45-degree field of view
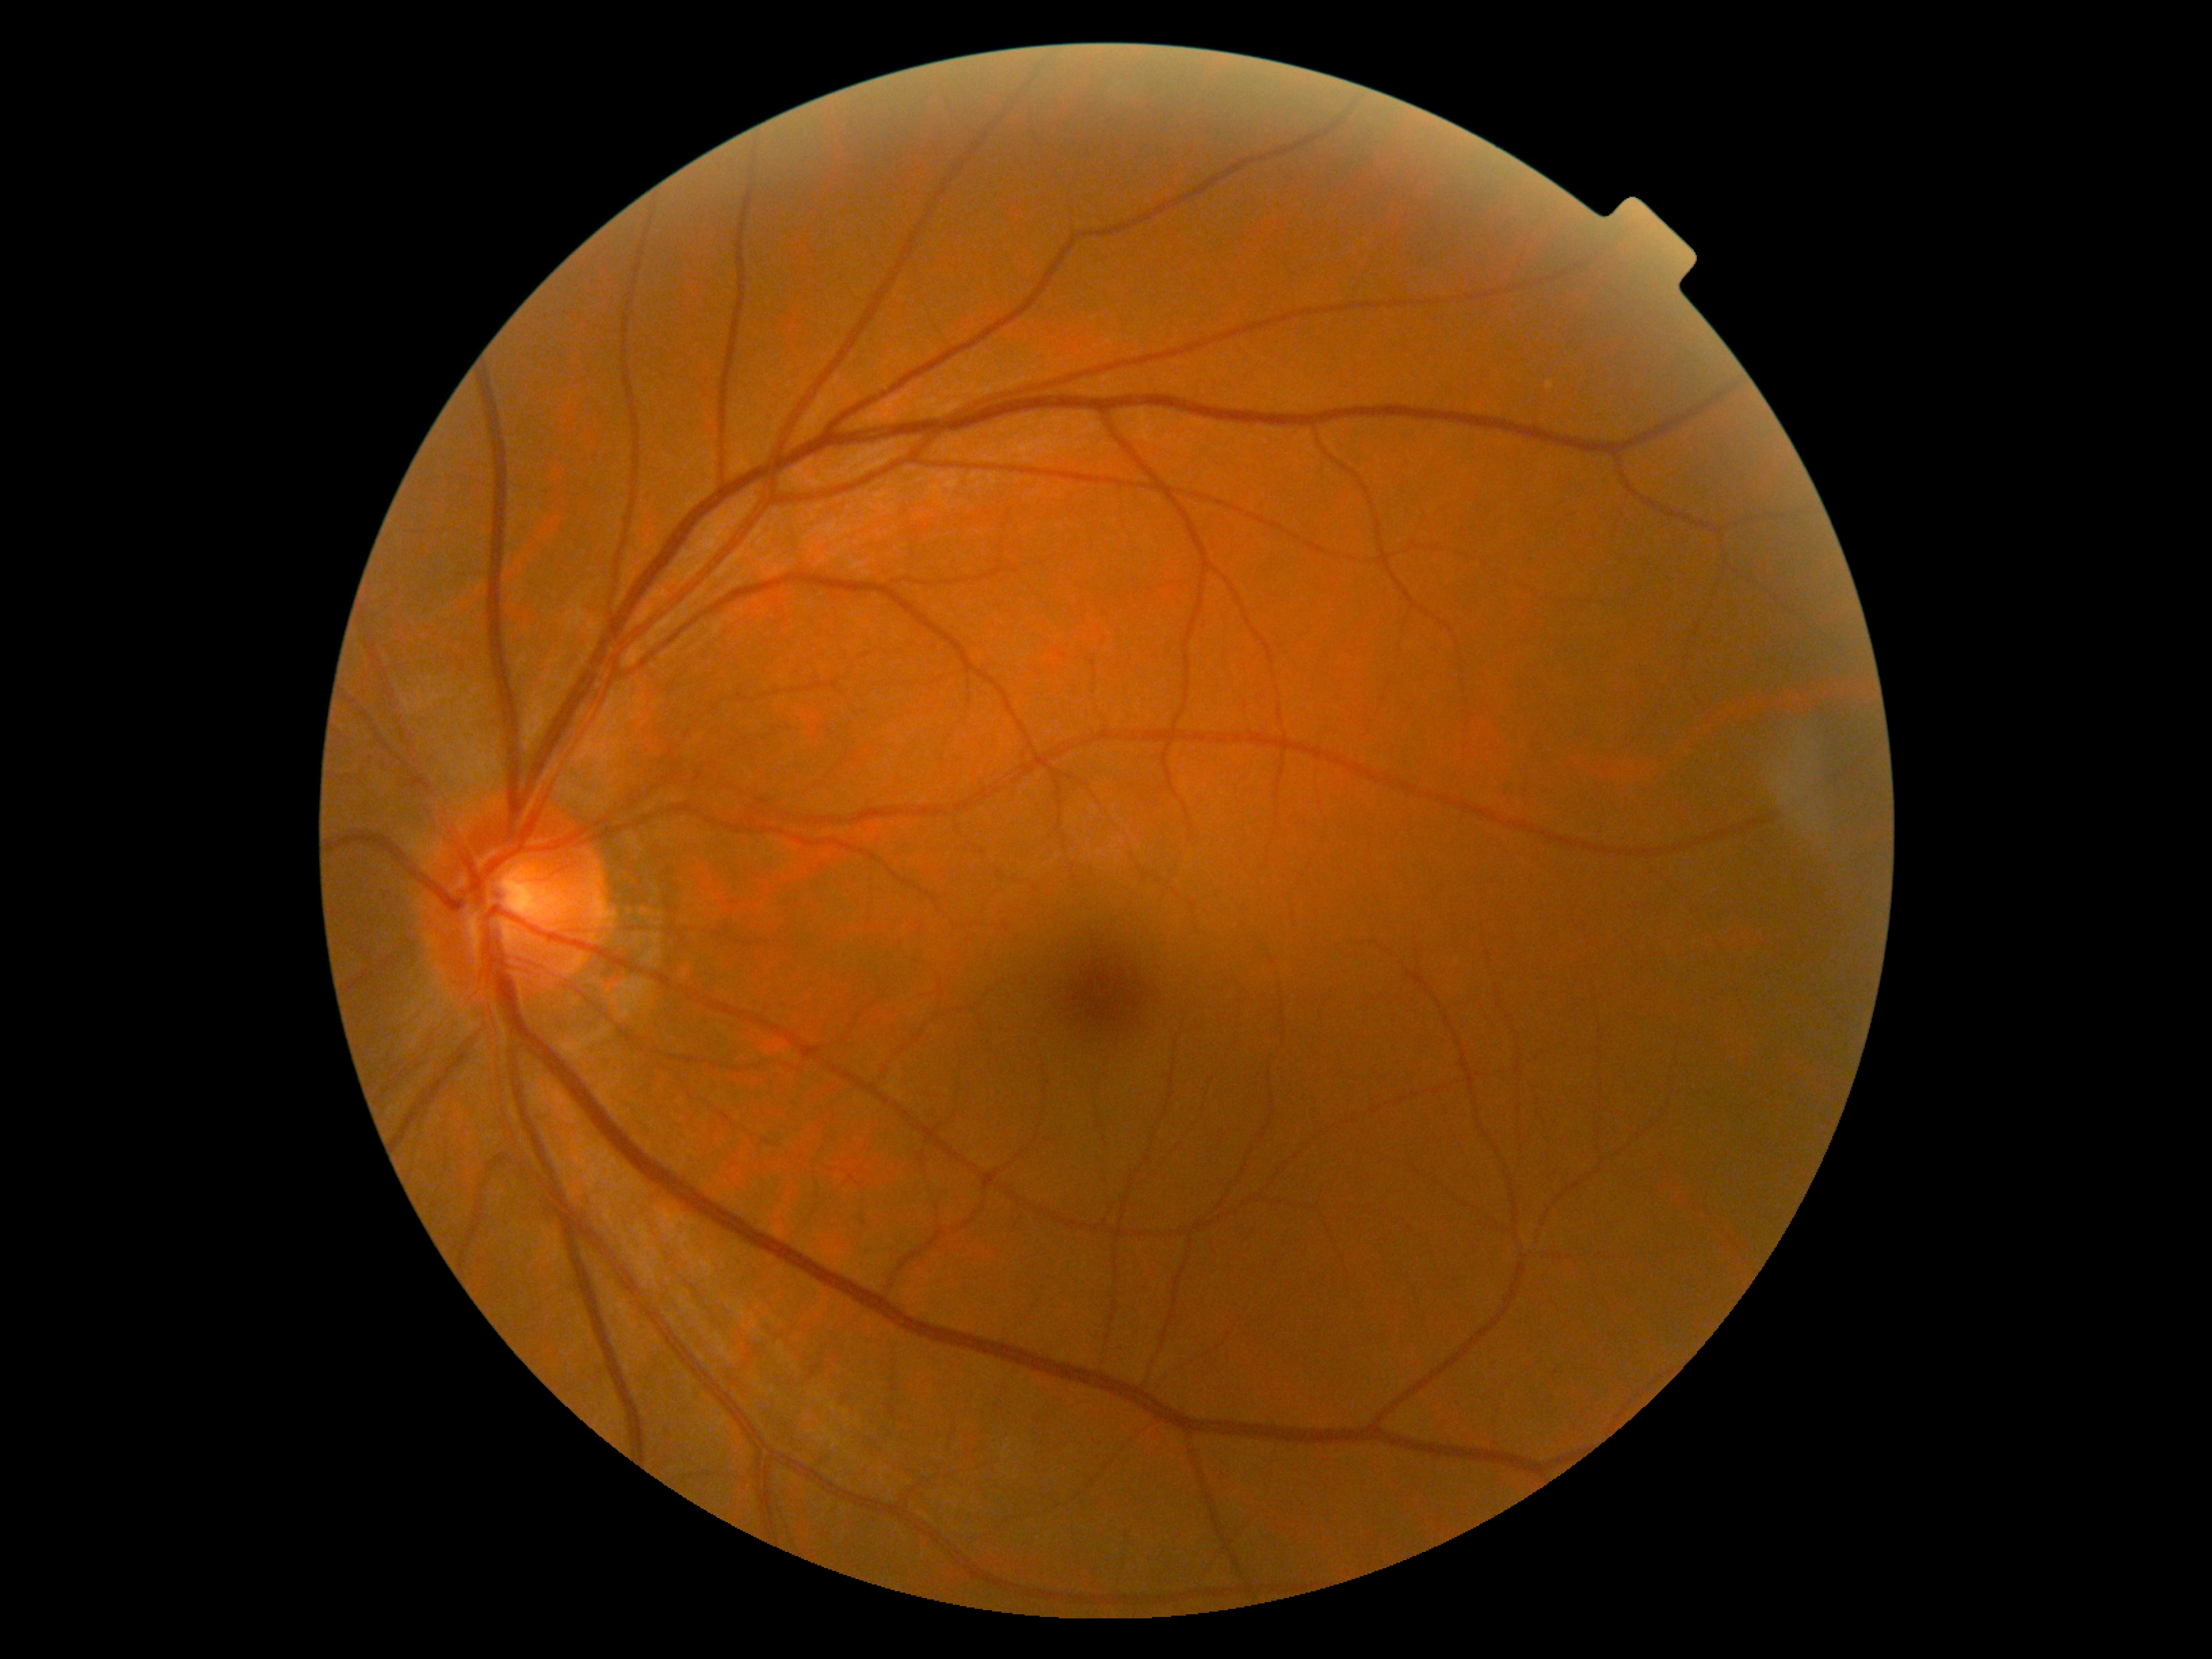 retinopathy: grade 0 (no apparent retinopathy).